848 x 848 pixels · no pharmacologic dilation
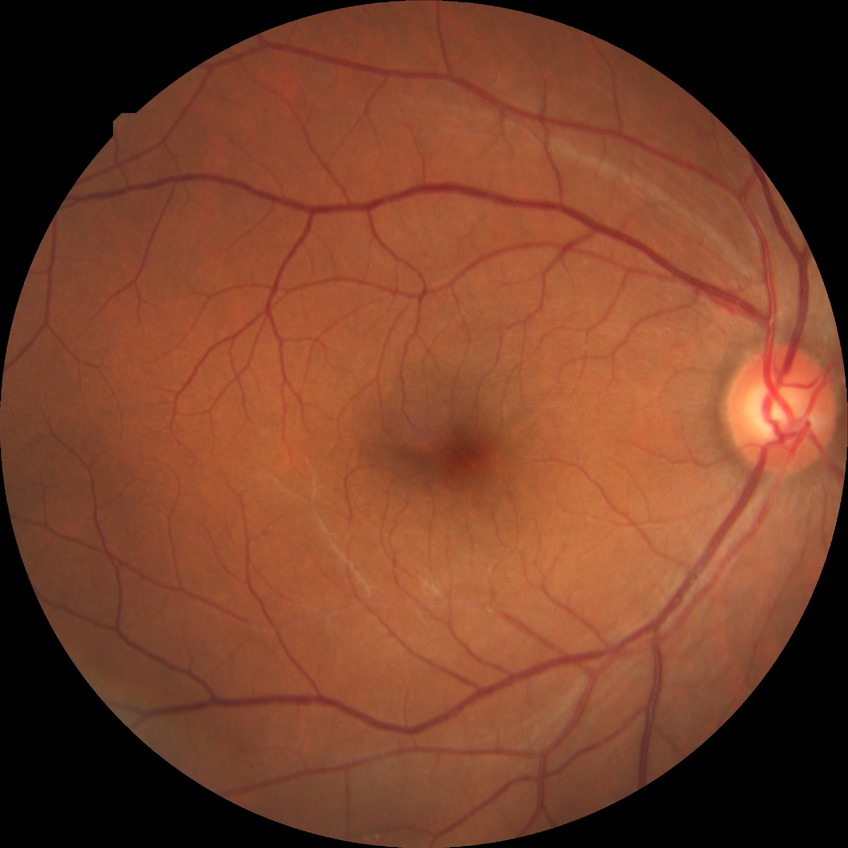

modified Davis classification = no diabetic retinopathy.